Modified Davis classification:
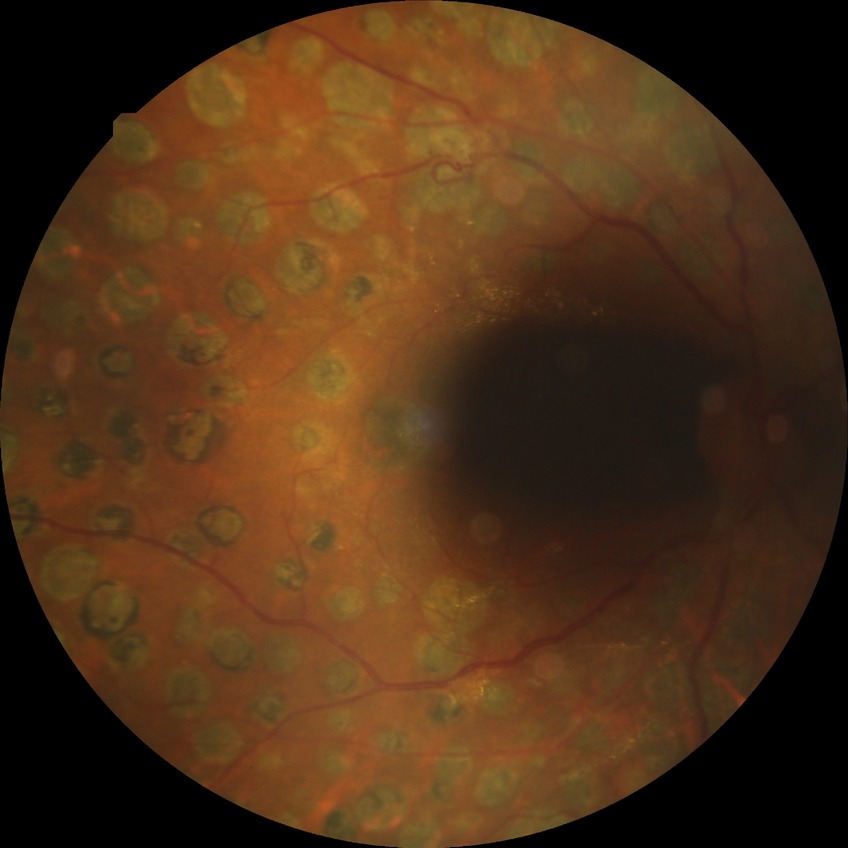 Diabetic retinopathy (DR): proliferative diabetic retinopathy (PDR).